FOV: 45 degrees · 412 x 310 pixels · color fundus photograph:
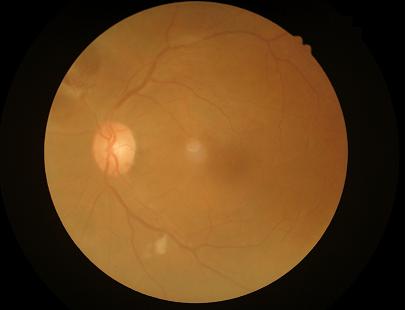 Sharpness = good; Overall = adequate; Contrast = low.